848x848px; 45° field of view; NIDEK AFC-230 — 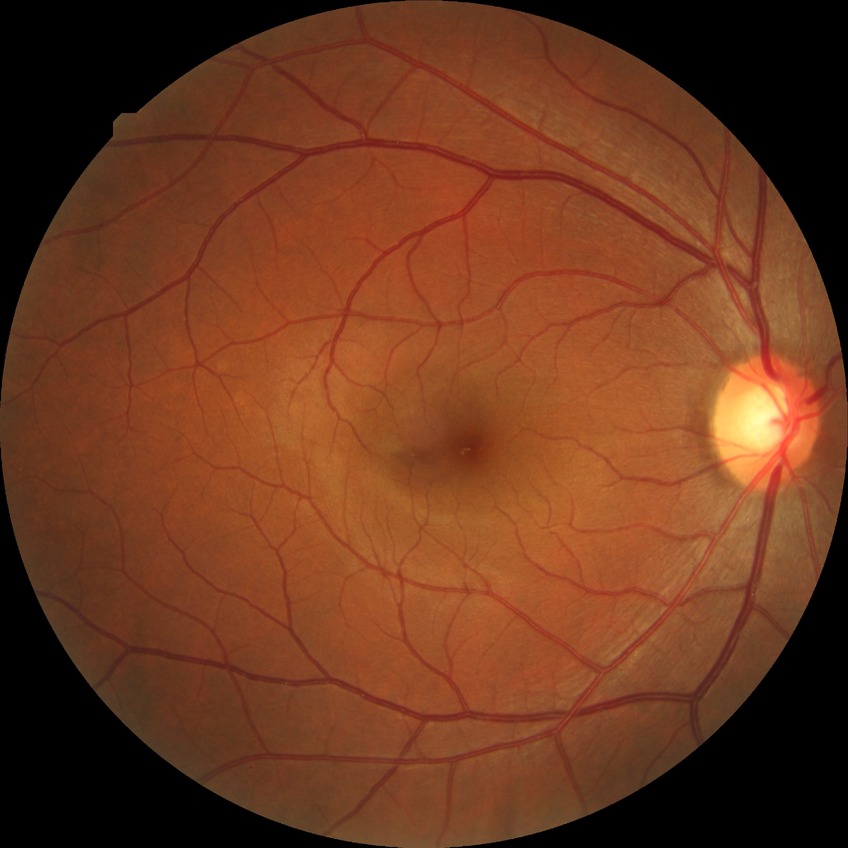

Retinopathy grade: no diabetic retinopathy.